Modified Davis grading. Nonmydriatic. Acquired with a NIDEK AFC-230: 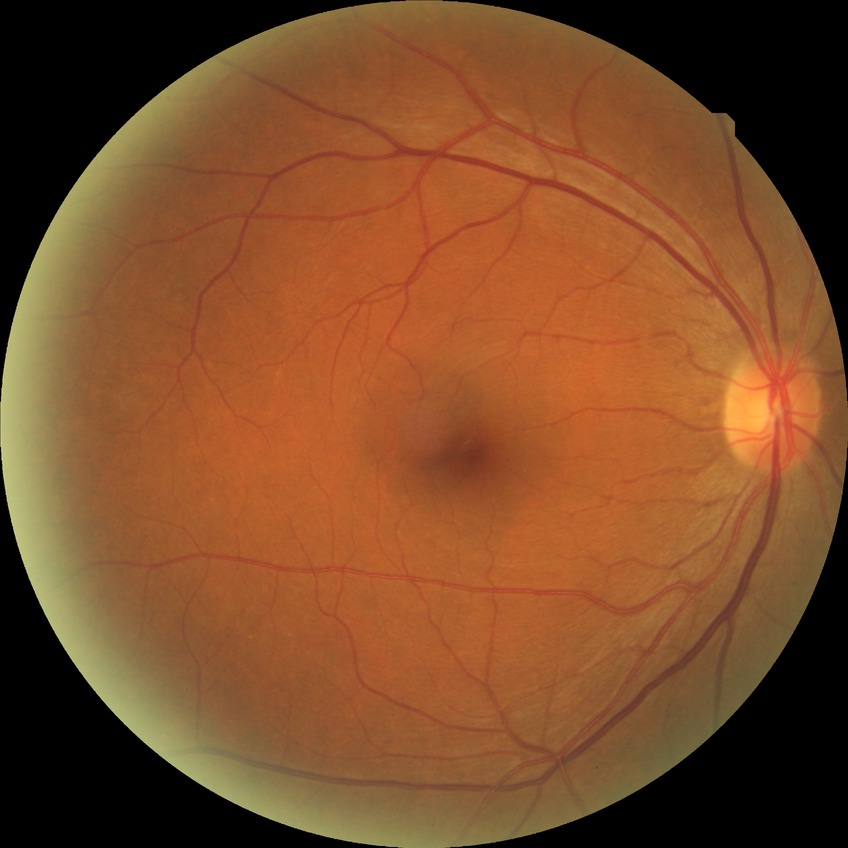
Diabetic retinopathy stage is no diabetic retinopathy.